DR severity per modified Davis staging. 45-degree field of view
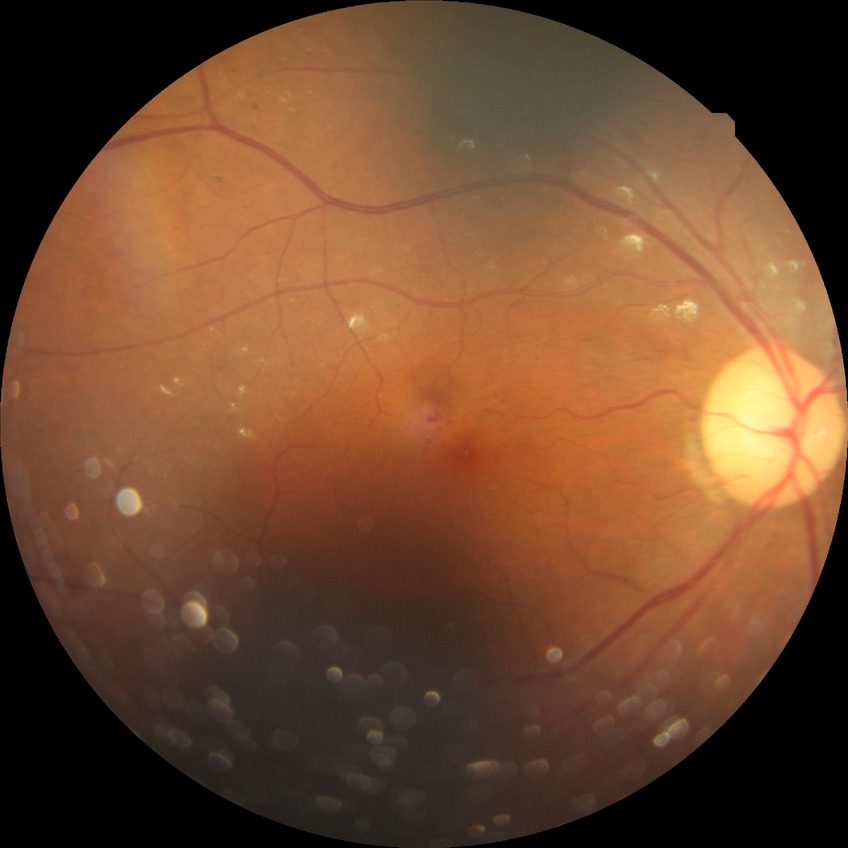
retinopathy grade@simple diabetic retinopathy.